CFP. Posterior pole view:
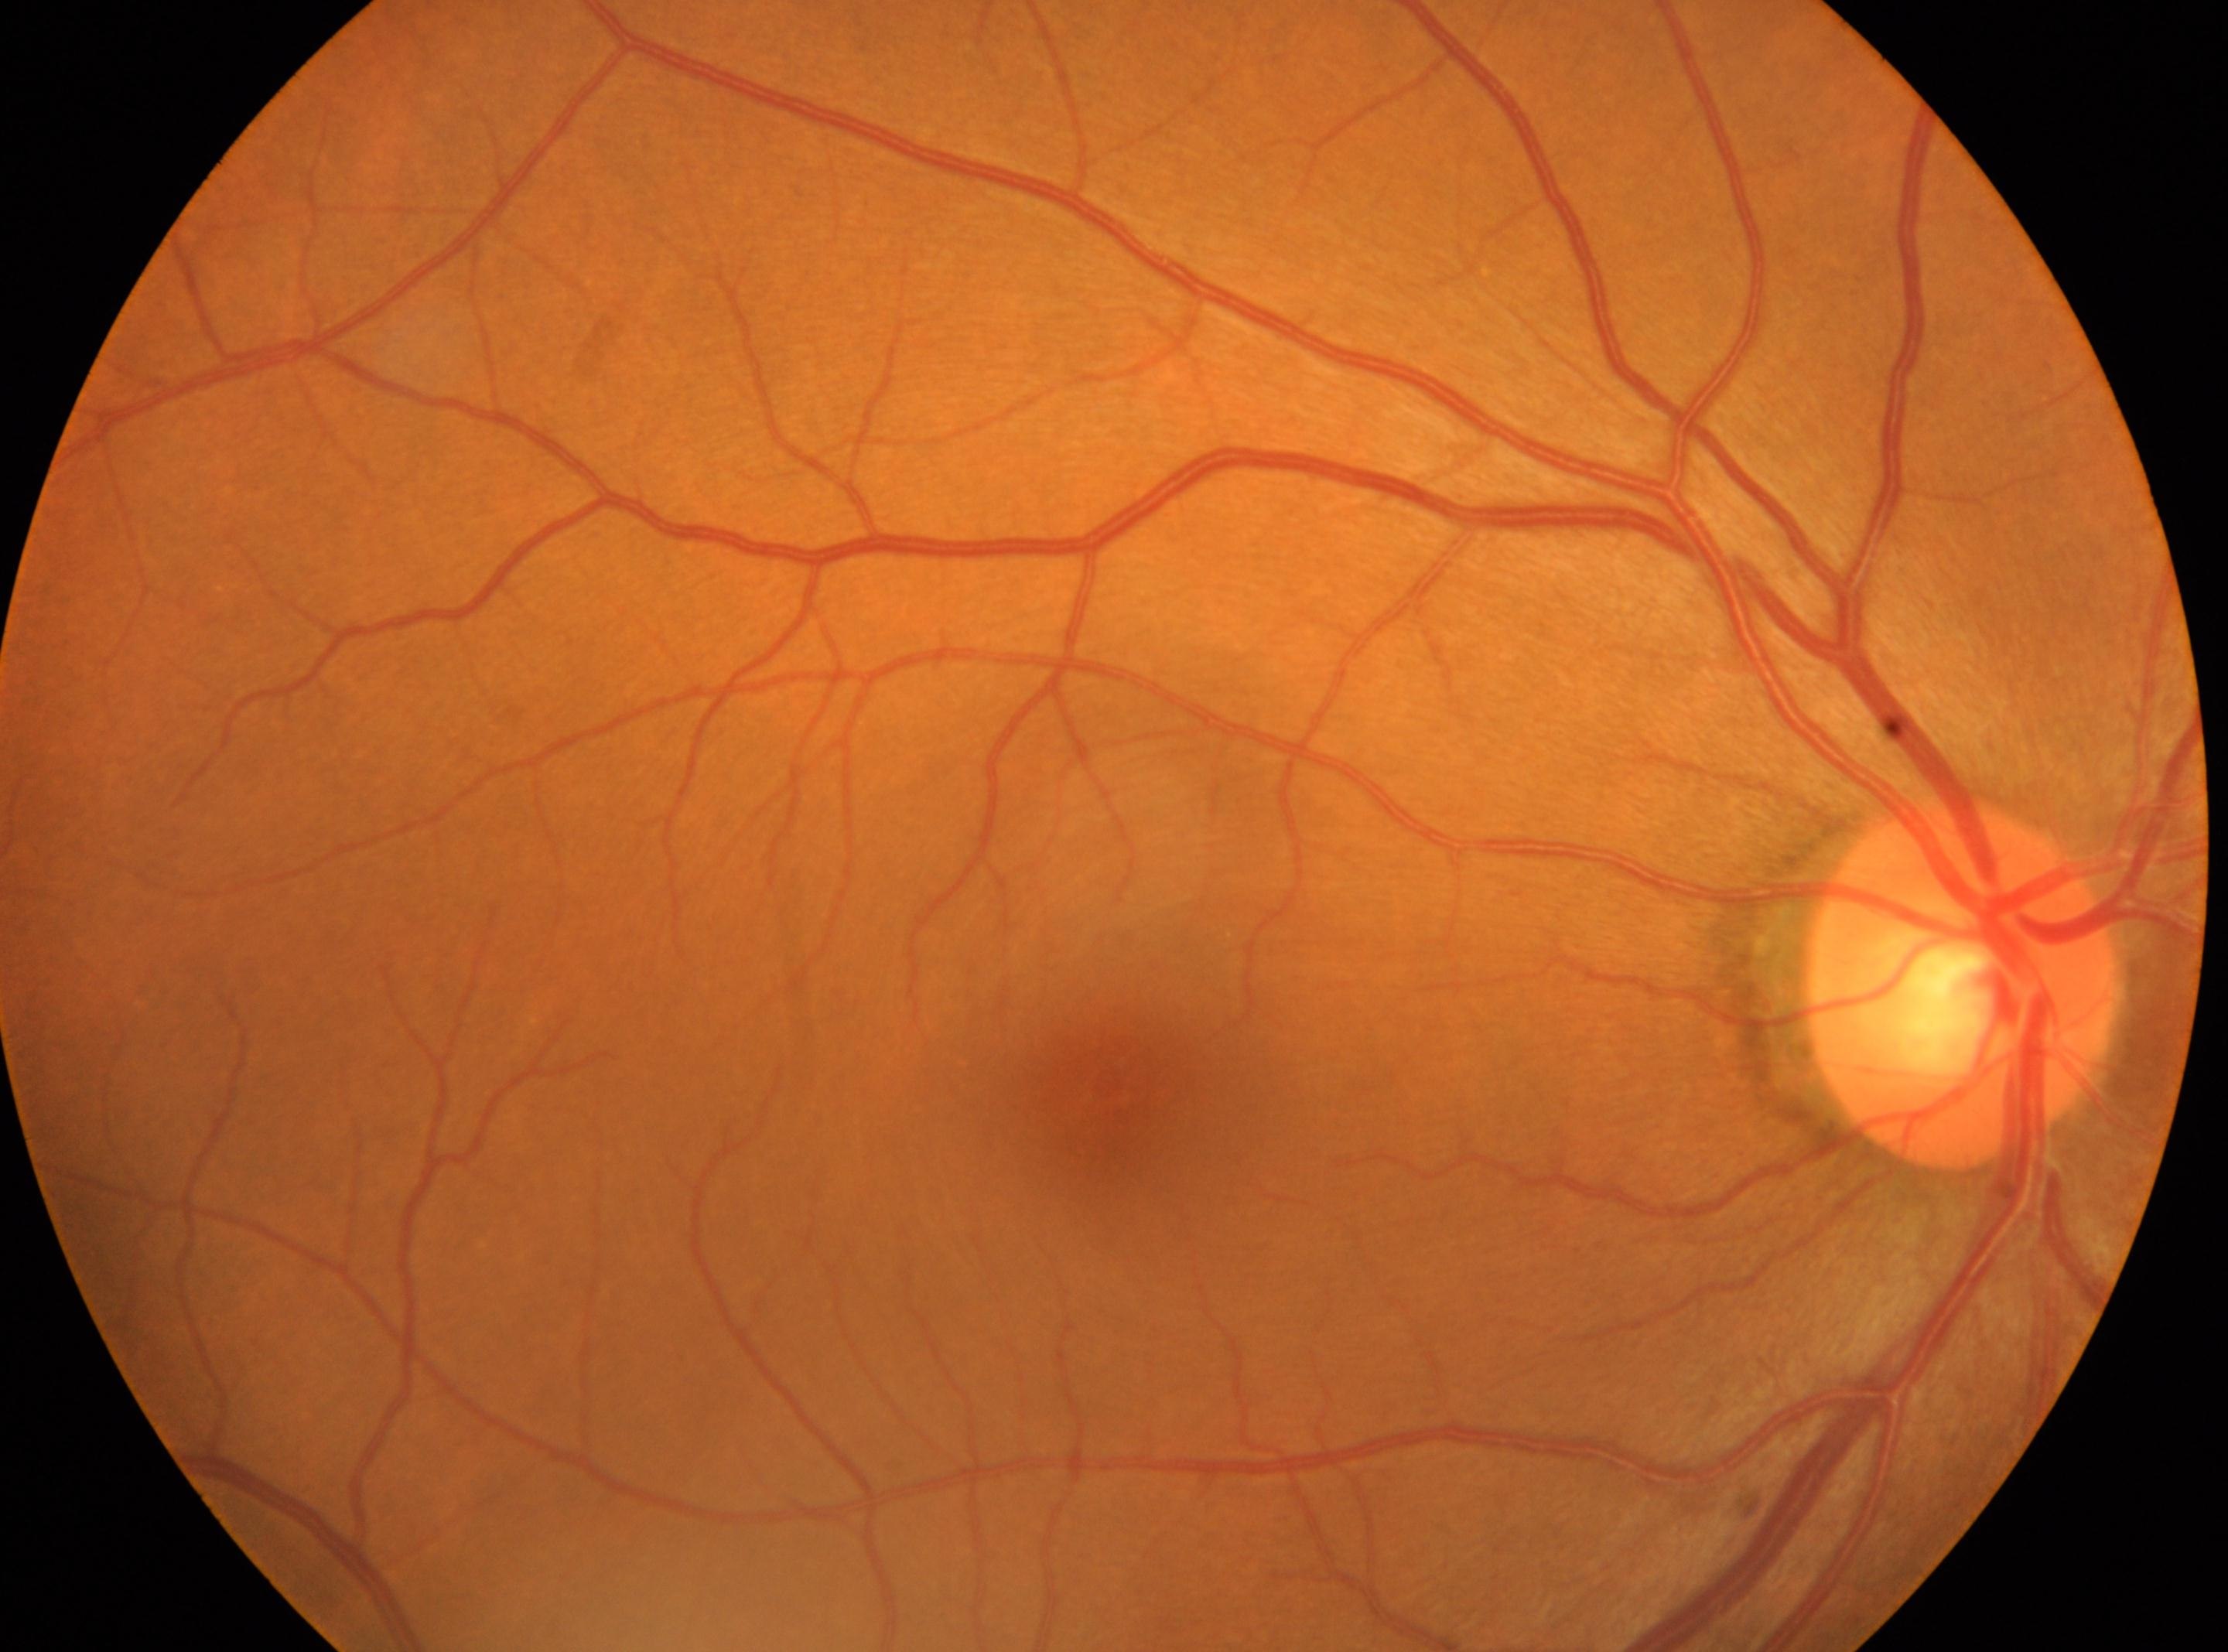
  optic_disc: (x=1962, y=981)
  dr_impression: No diabetic retinal disease findings
  dr_grade: 0
  fovea: (x=1111, y=1087)
  eye: right eye